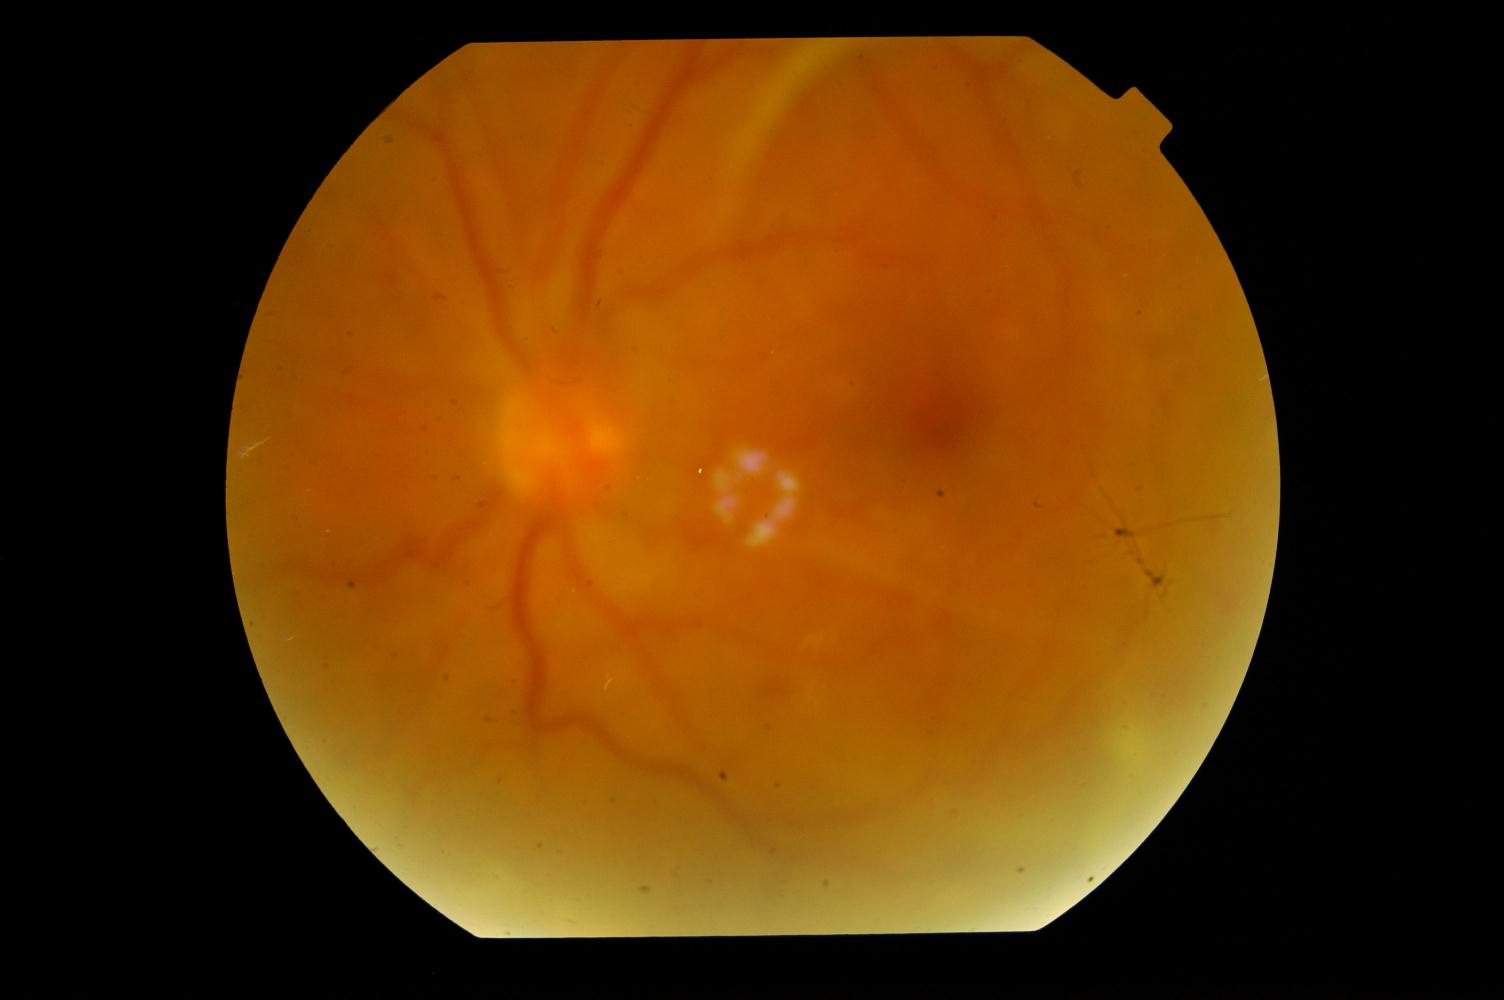 Impression: diabetic retinopathy.